1469x1472px — 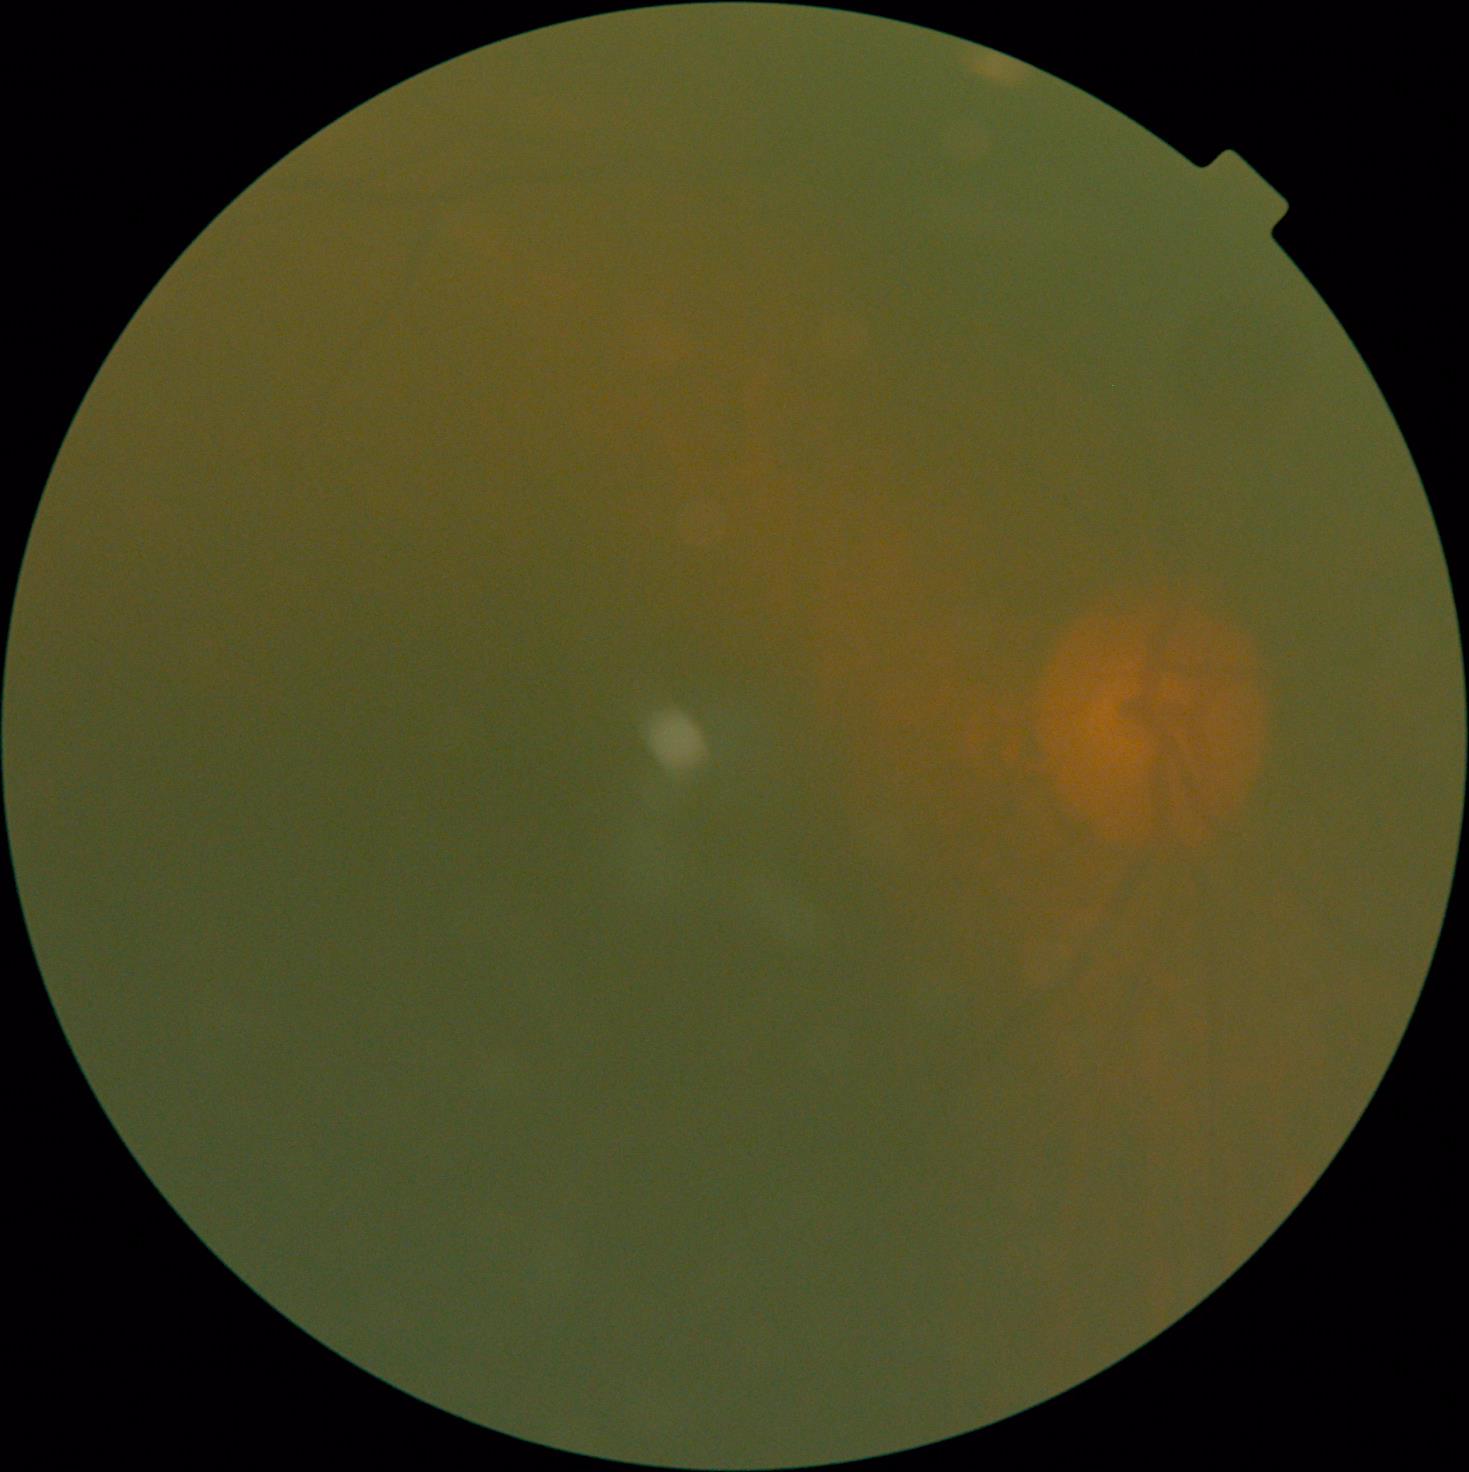
Retinopathy grade: ungradable due to poor image quality. Image quality is insufficient for diabetic retinopathy assessment.